Color fundus image · 2212 x 1659 pixels:
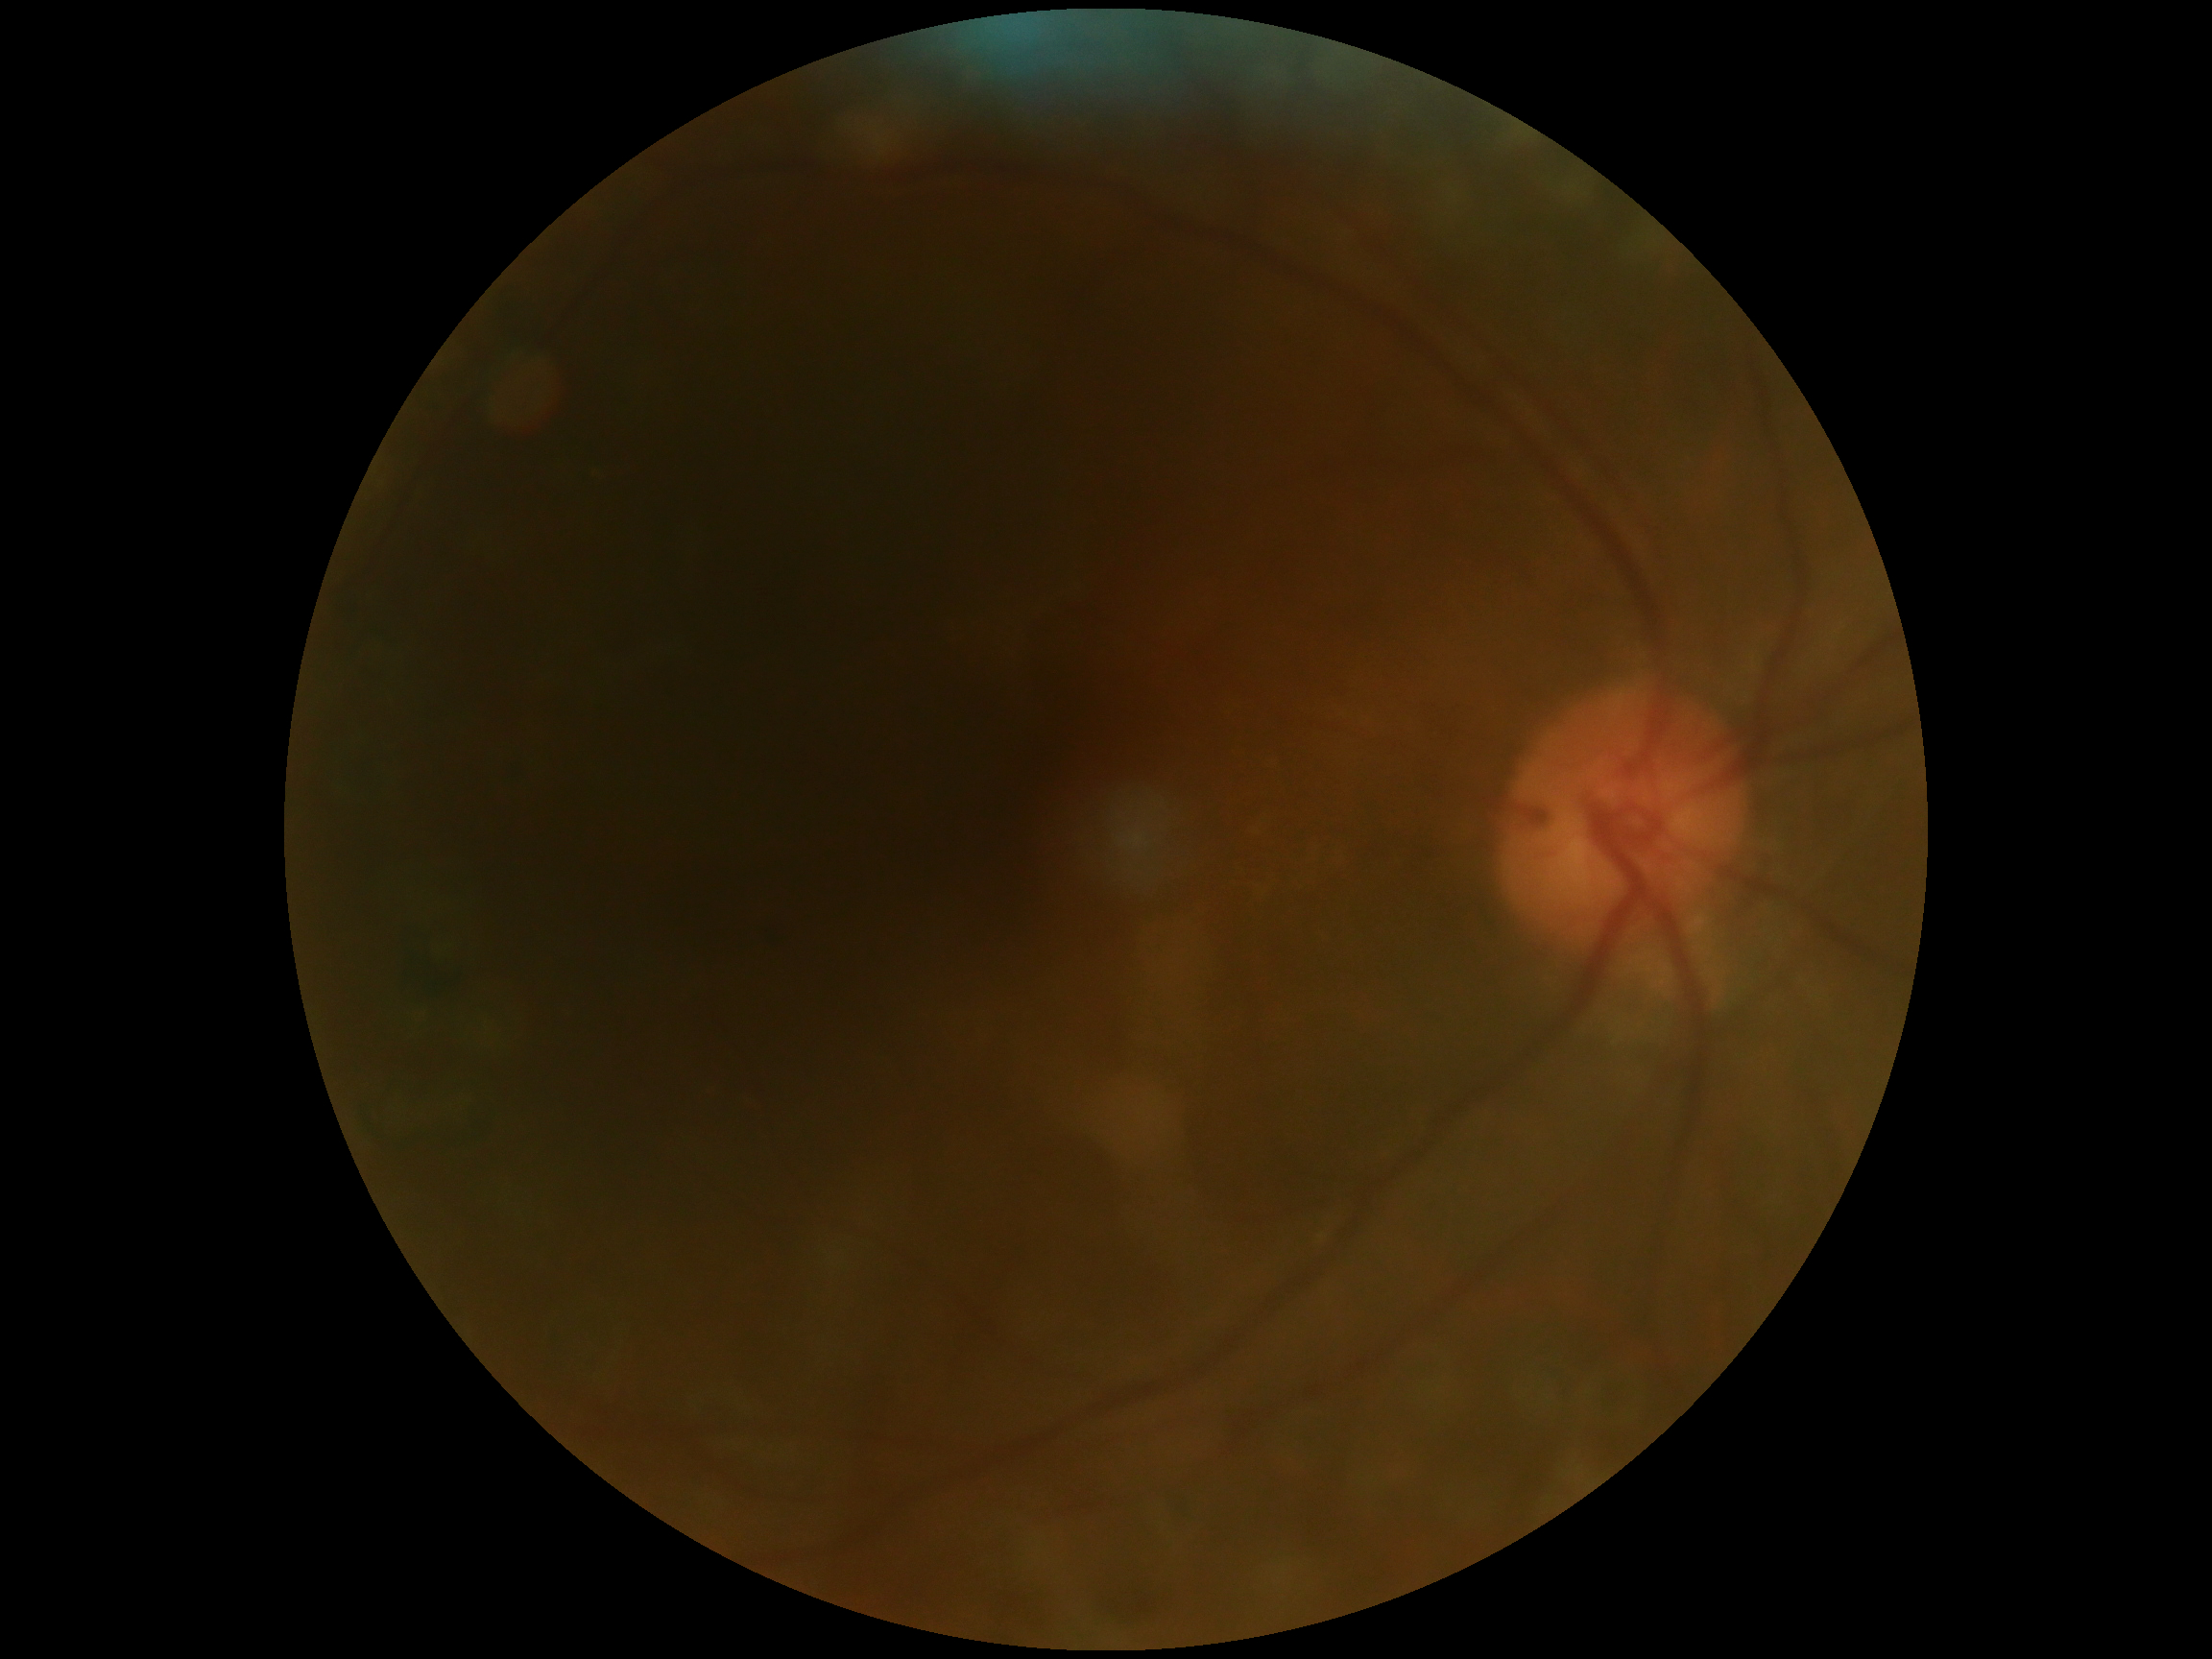 DR severity is 0/4 — no visible signs of diabetic retinopathy.